1240 x 1240 pixels · pediatric wide-field fundus photograph — 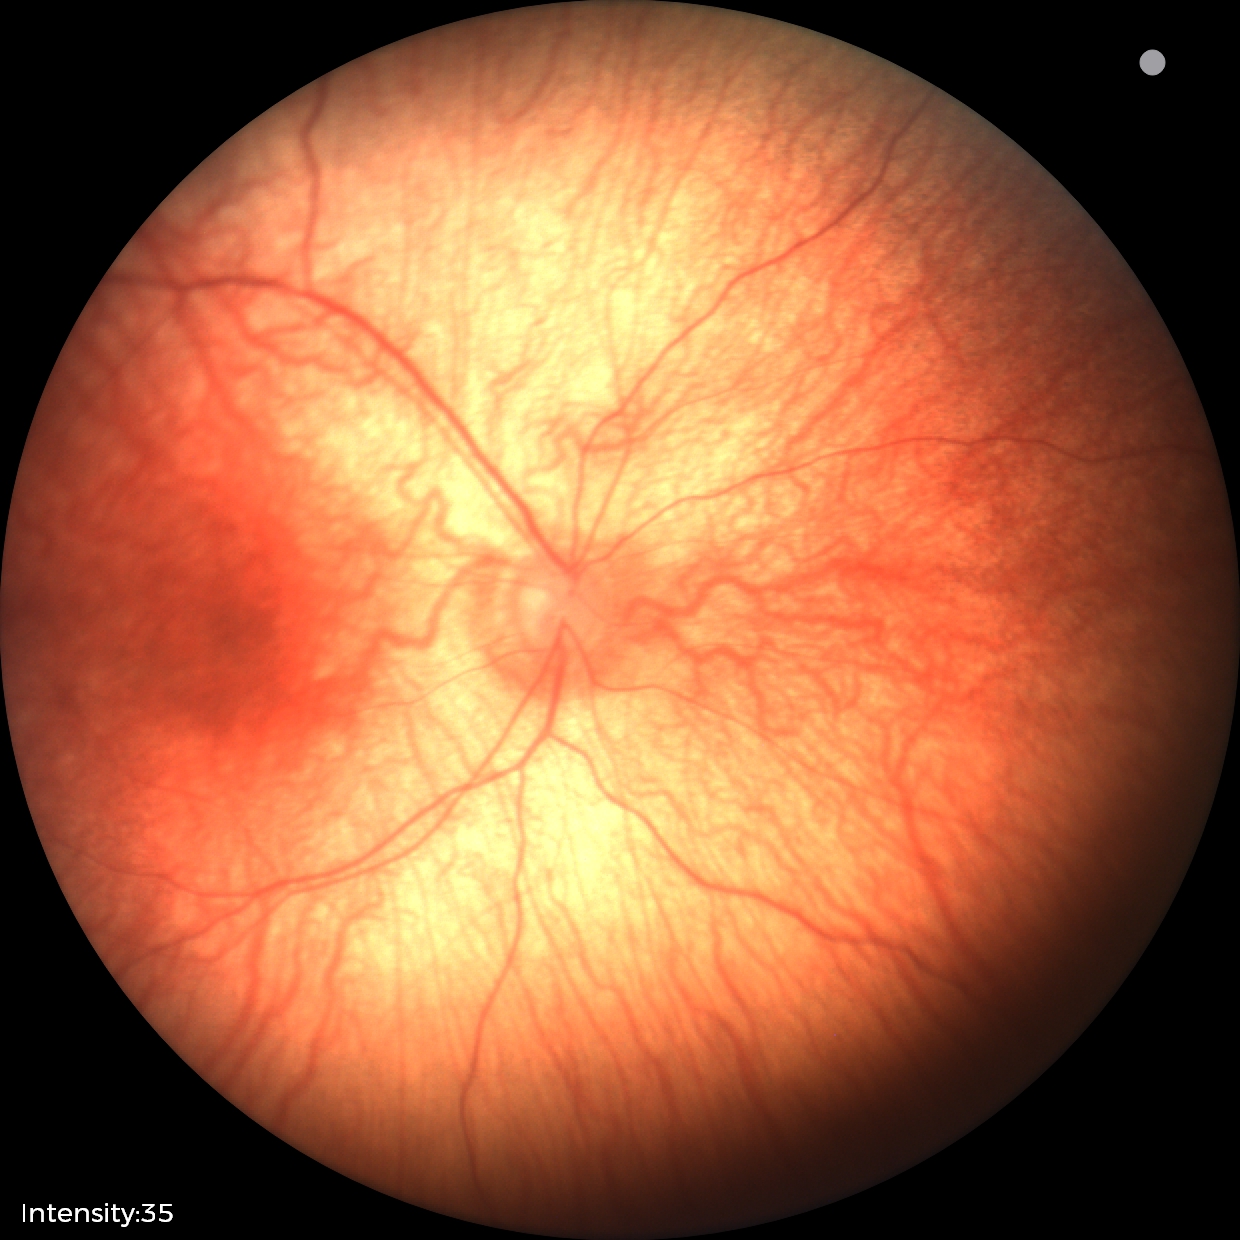 Impression = physiological.